1240x1240px; Phoenix ICON, 100° FOV; pediatric wide-field fundus photograph:
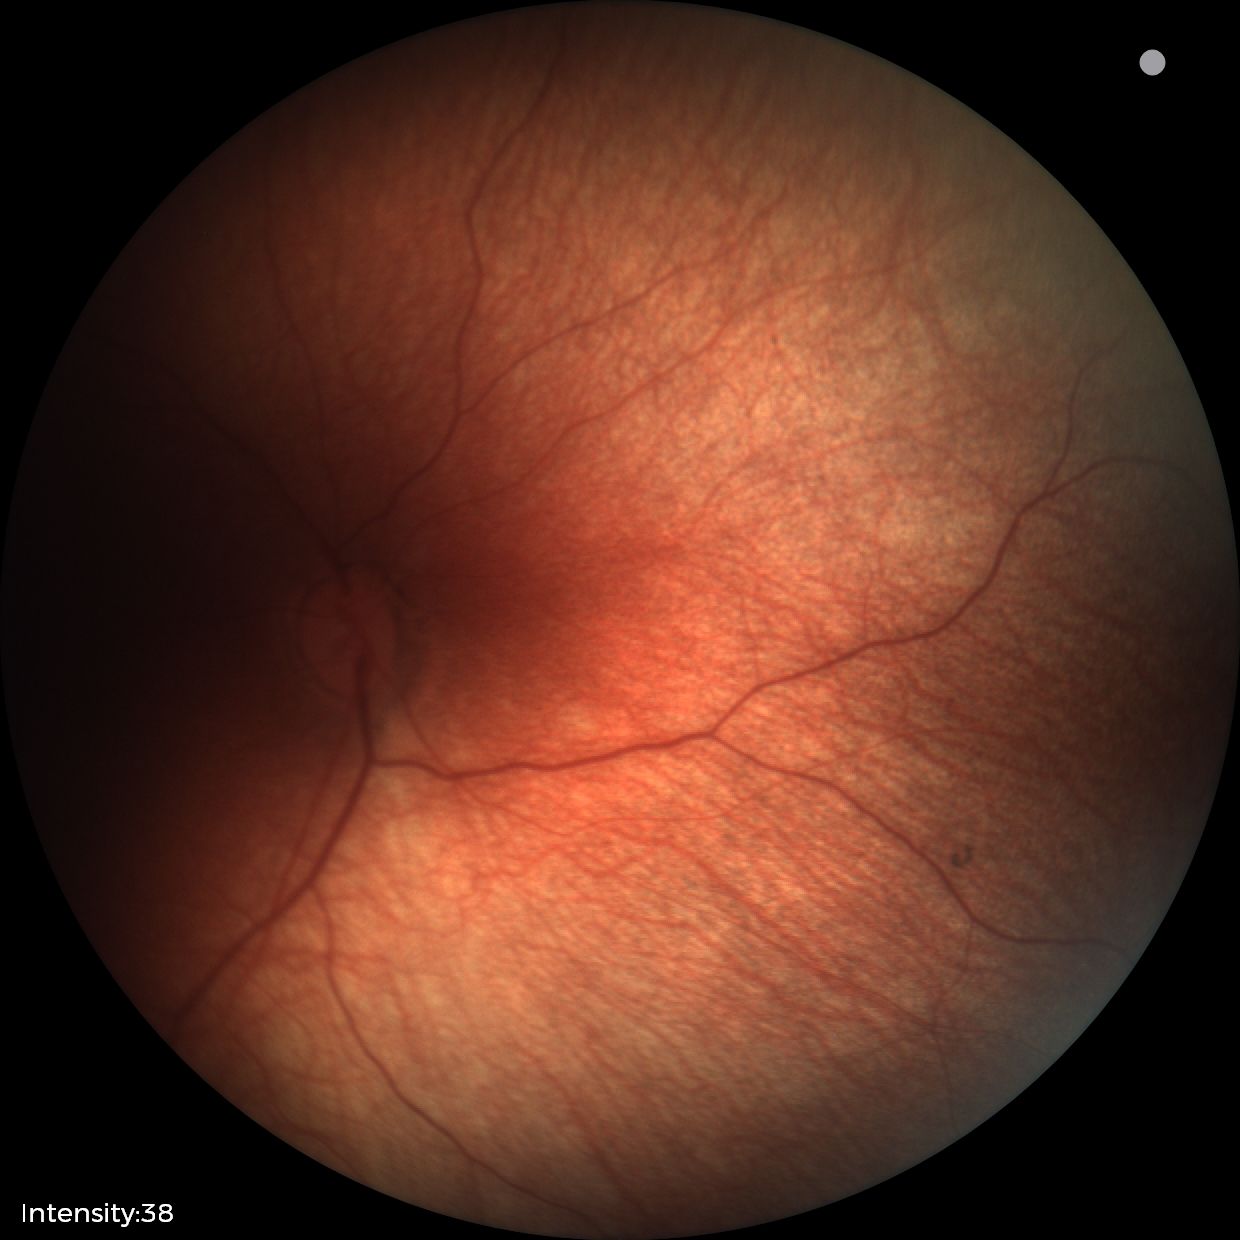

Examination with physiological retinal findings.